No pharmacologic dilation.
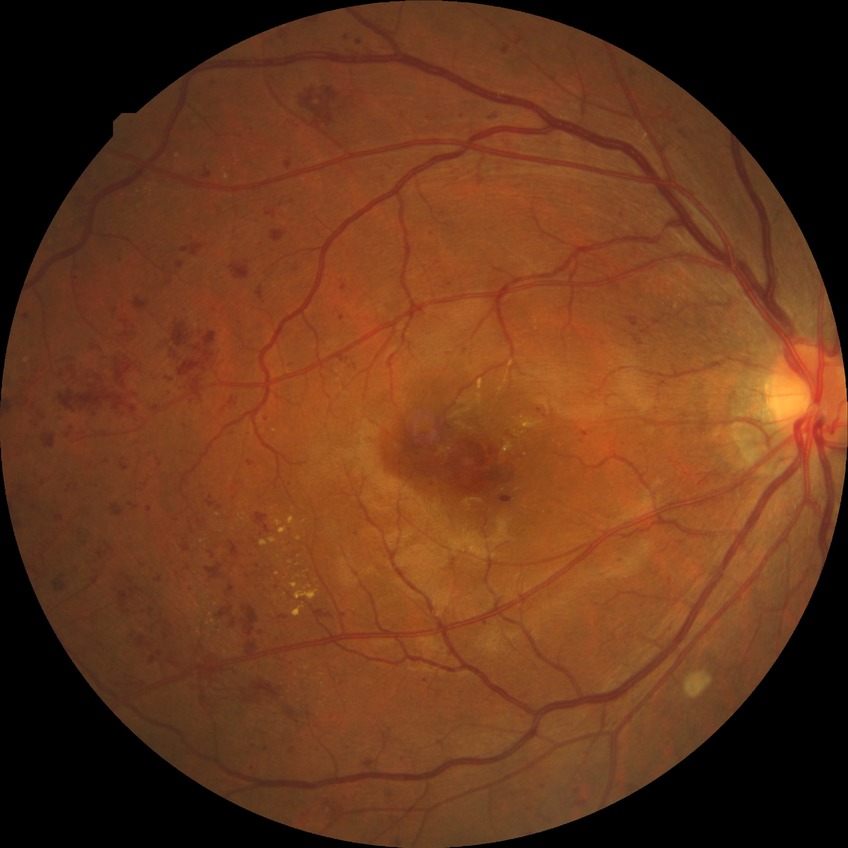

Davis DR grade: SDR.